848x848 · fundus photo · nonmydriatic fundus photograph · 45 degree fundus photograph — 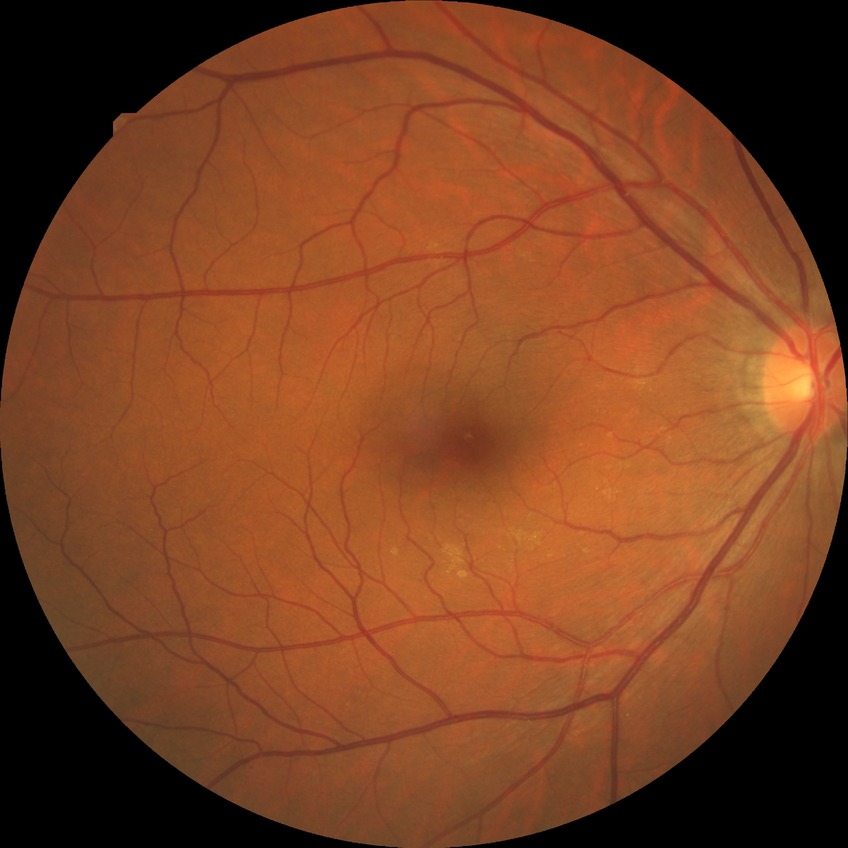

Modified Davis grading: no diabetic retinopathy.